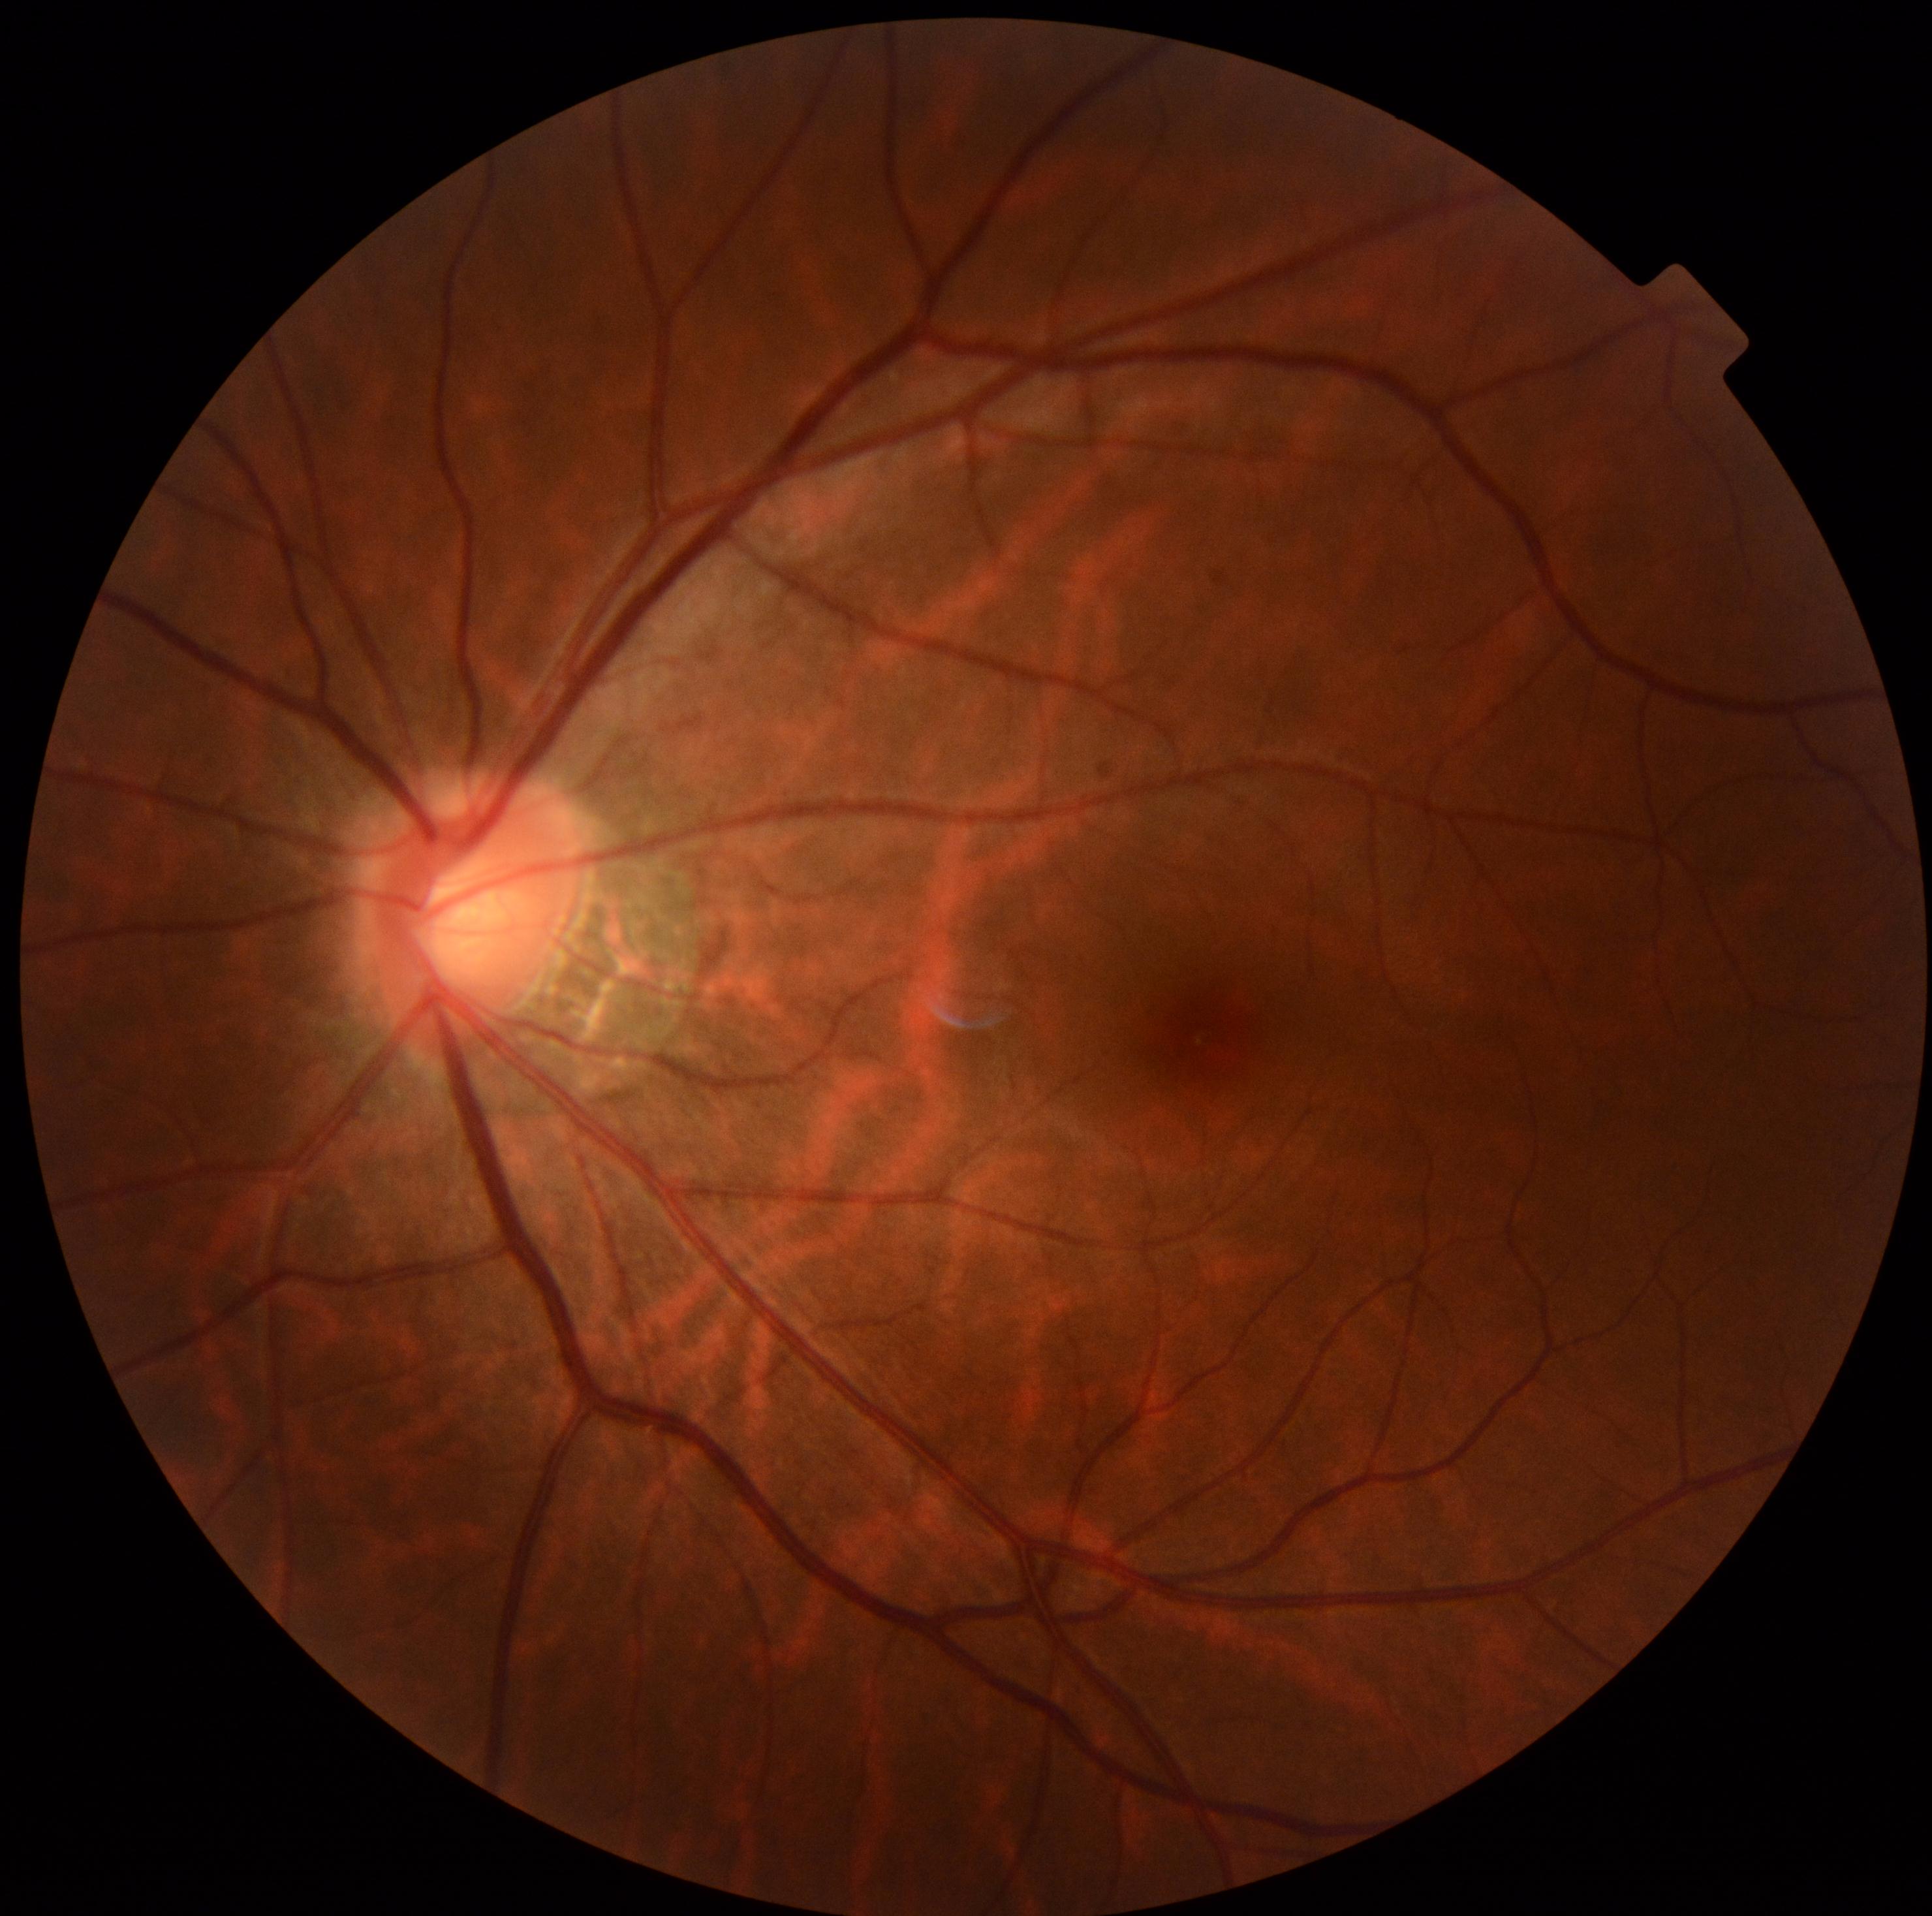 Diabetic retinopathy grade is 0 (no apparent retinopathy). No diabetic retinal disease findings.